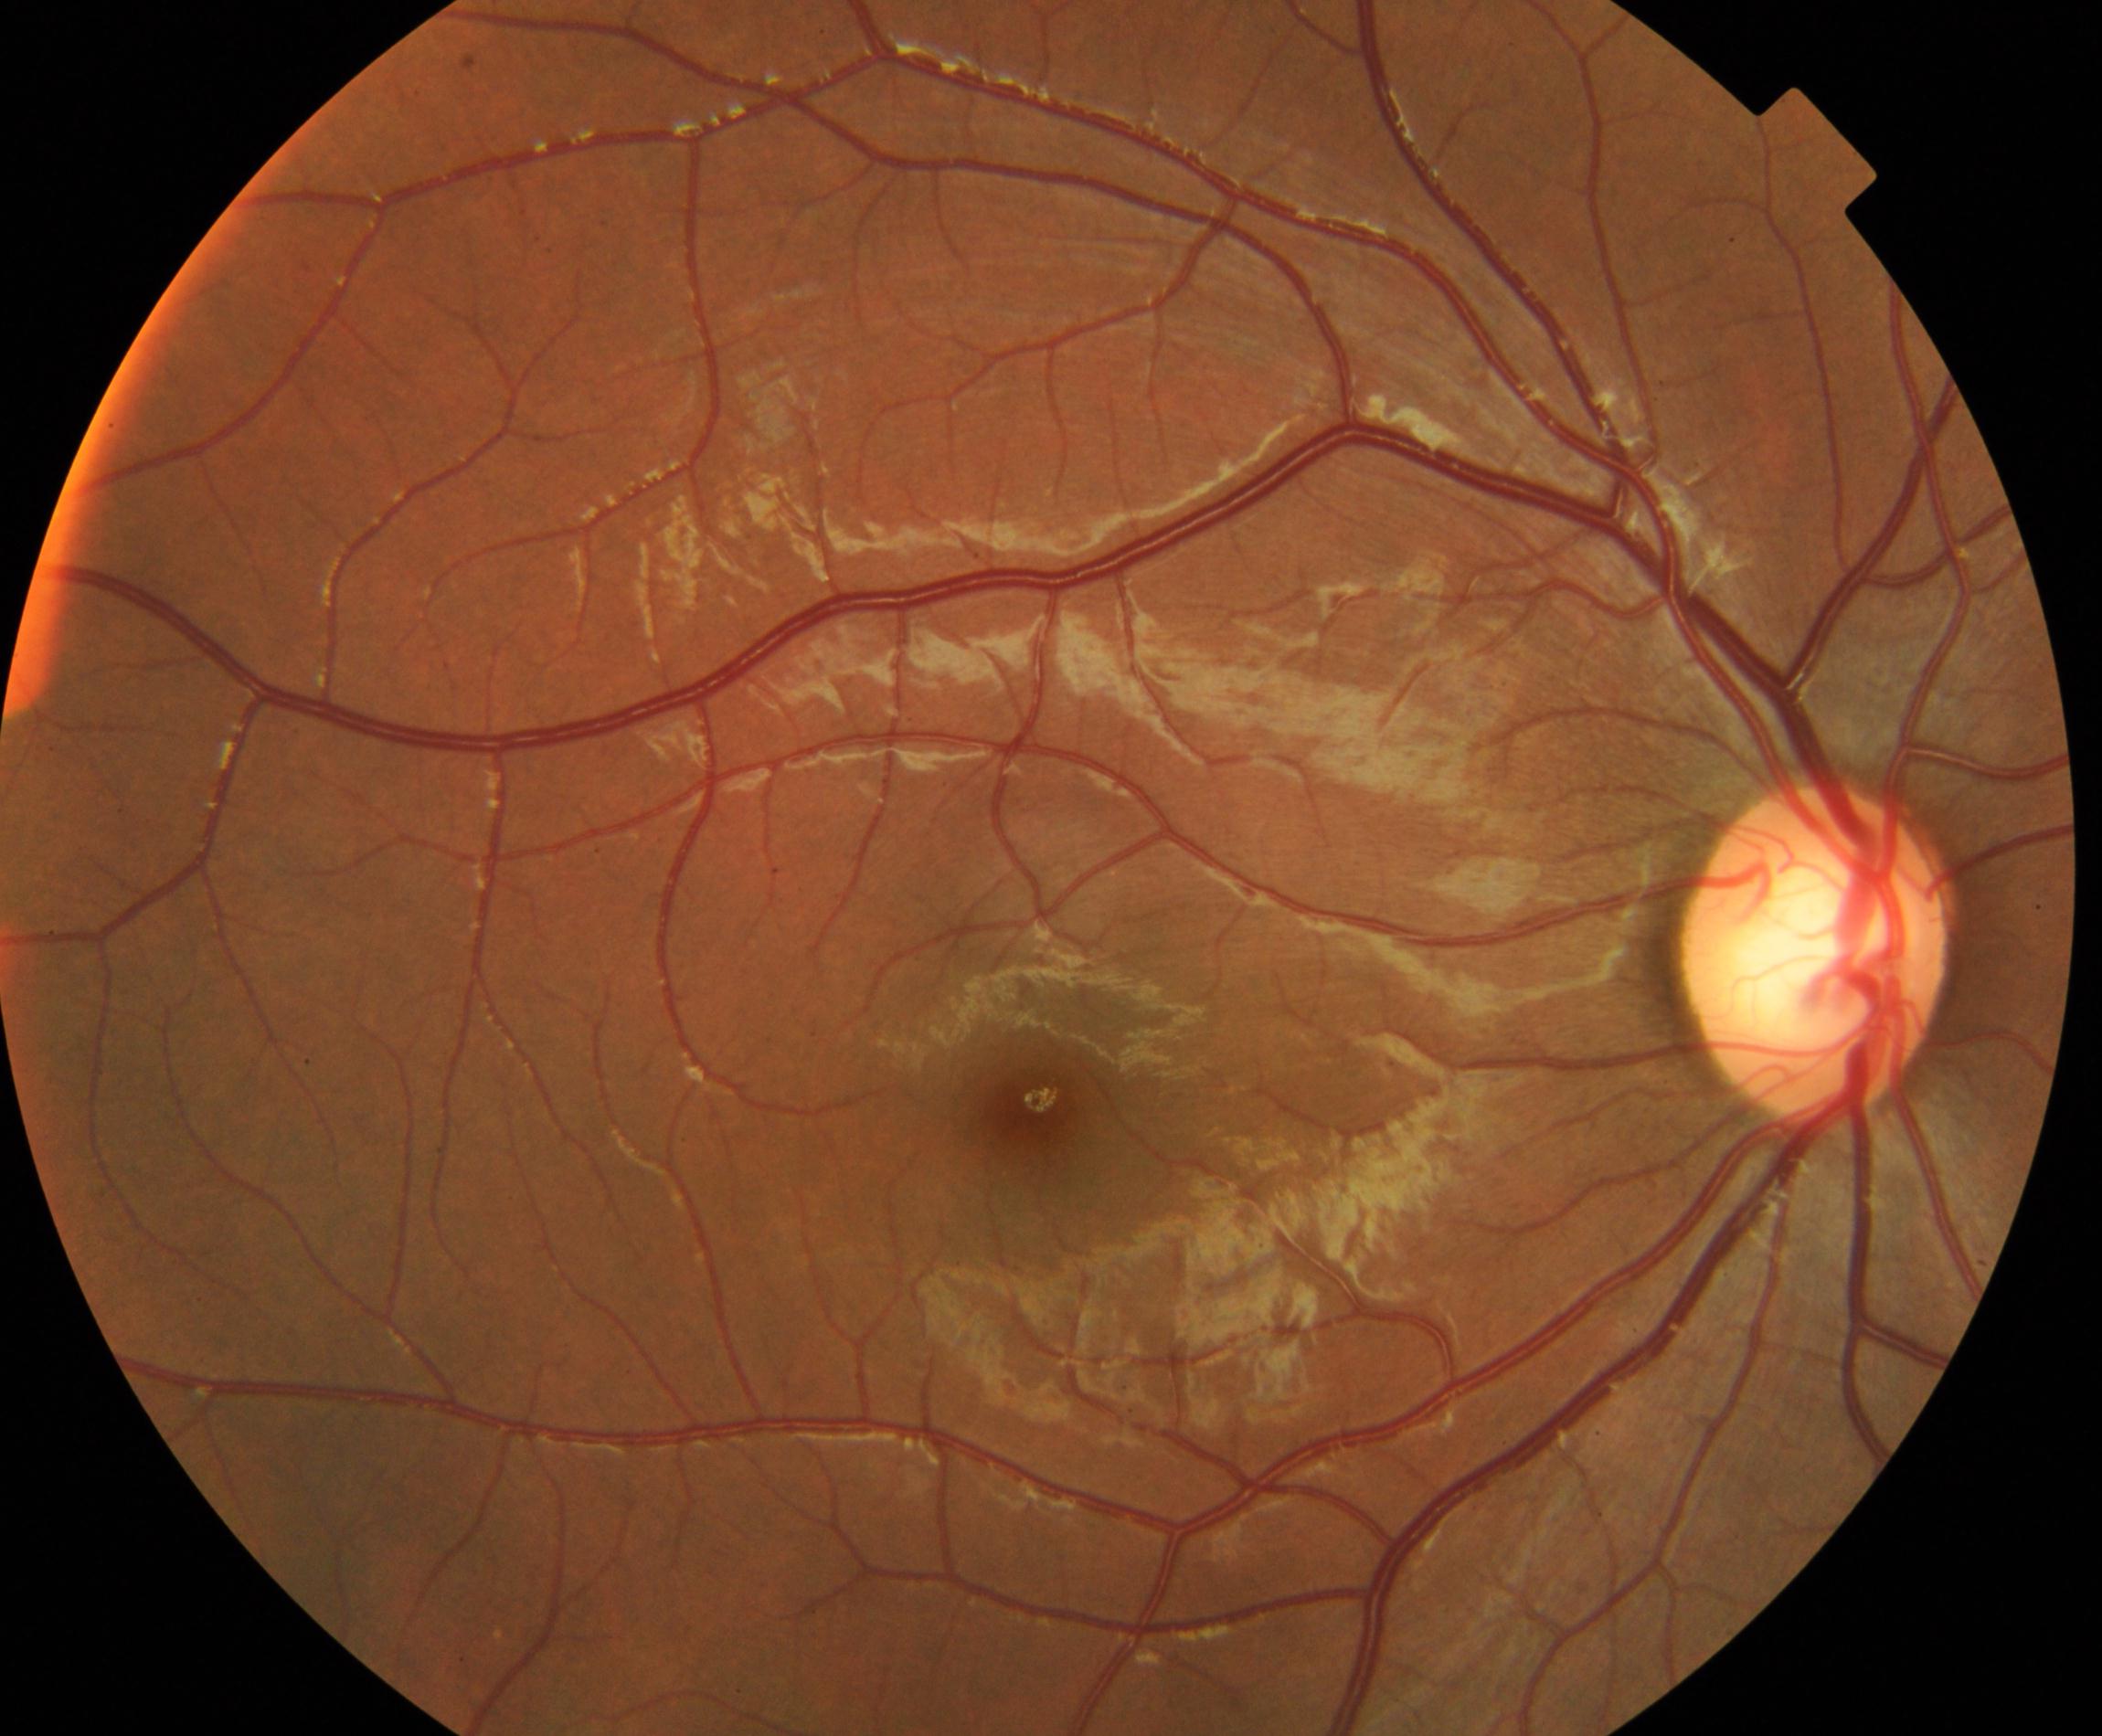
Diagnosis: large optic cup.